Acquired with a NIDEK AFC-230; graded on the modified Davis scale: 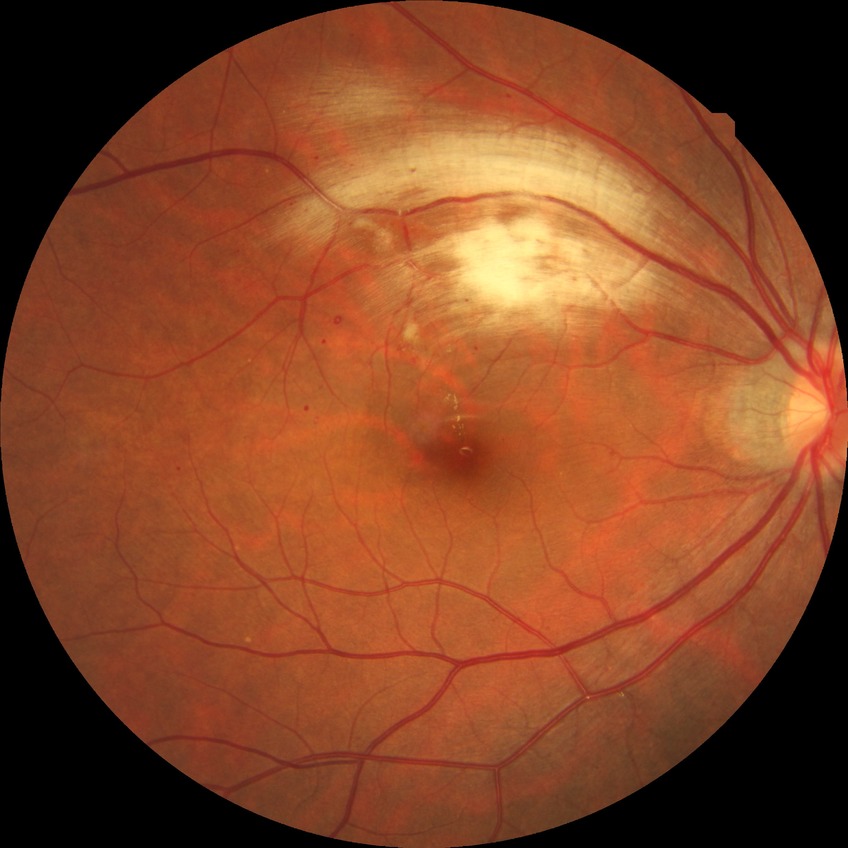 {
  "proliferative_class": "non-proliferative diabetic retinopathy",
  "davis_grade": "simple diabetic retinopathy (SDR)"
}